Retinal fundus photograph. NIDEK AFC-230. 45 degree fundus photograph:
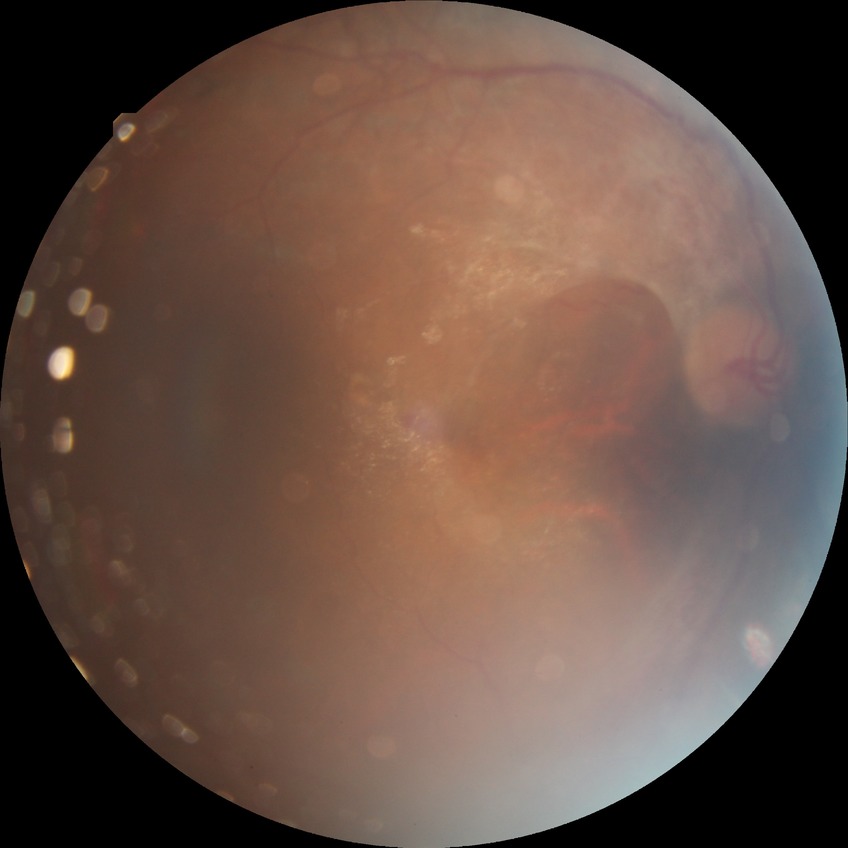
  davis_grade: PDR (proliferative diabetic retinopathy)